Color fundus photograph
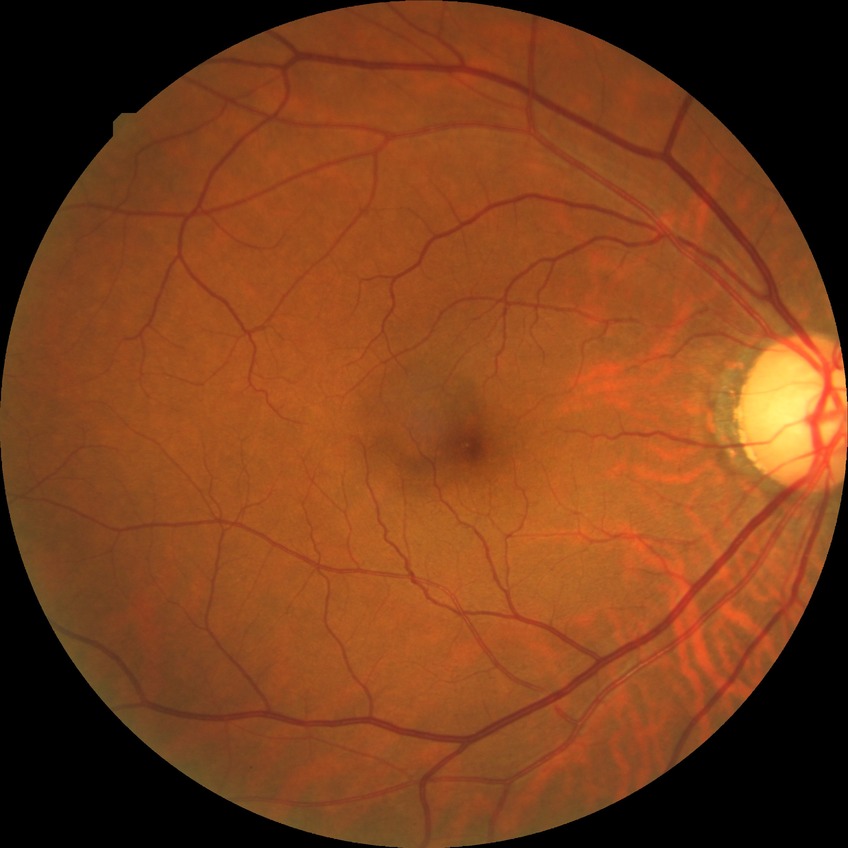

Diabetic retinopathy (DR) is no diabetic retinopathy (NDR).